Modified Davis grading:
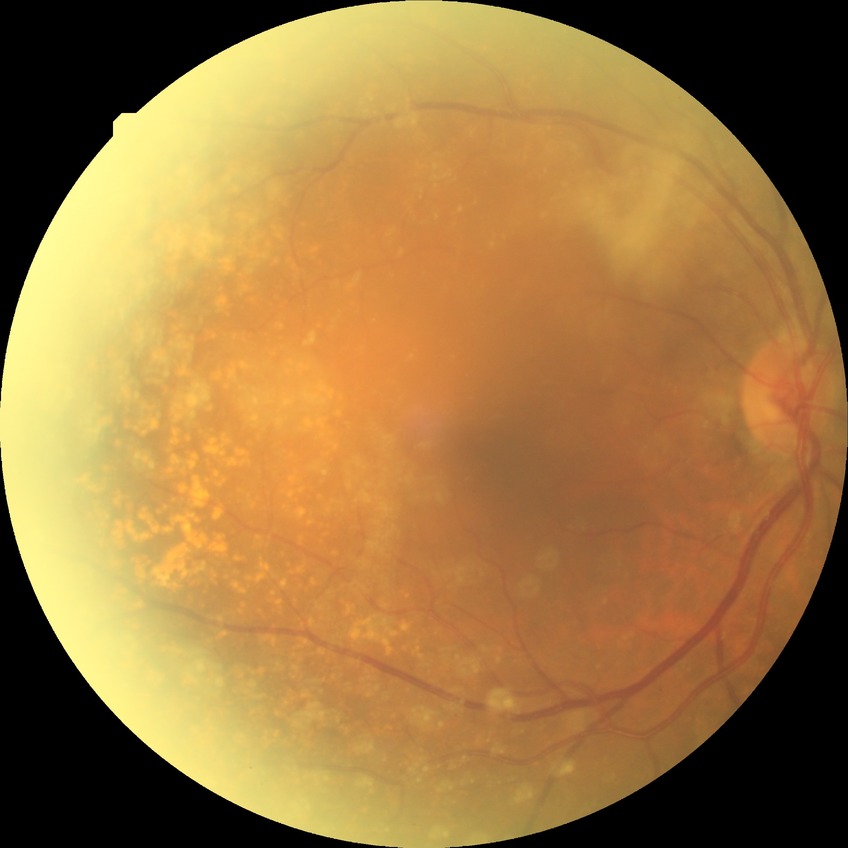

Diabetic retinopathy (DR): no diabetic retinopathy (NDR).